130° field of view (Clarity RetCam 3); pediatric retinal photograph (wide-field).
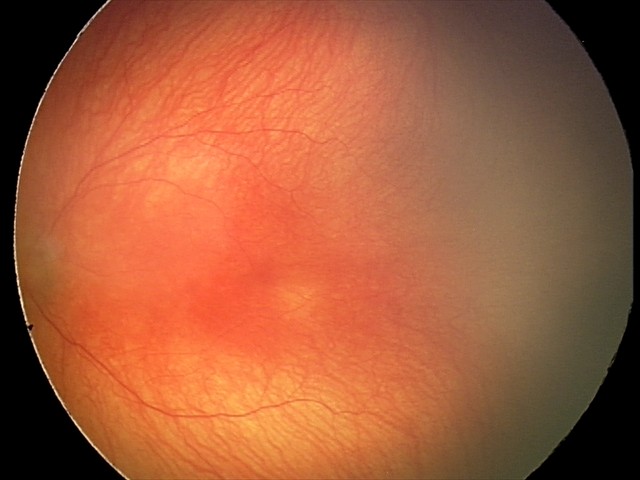

Screening examination consistent with aggressive retinopathy of prematurity. Plus disease was diagnosed.